Fundus photo — 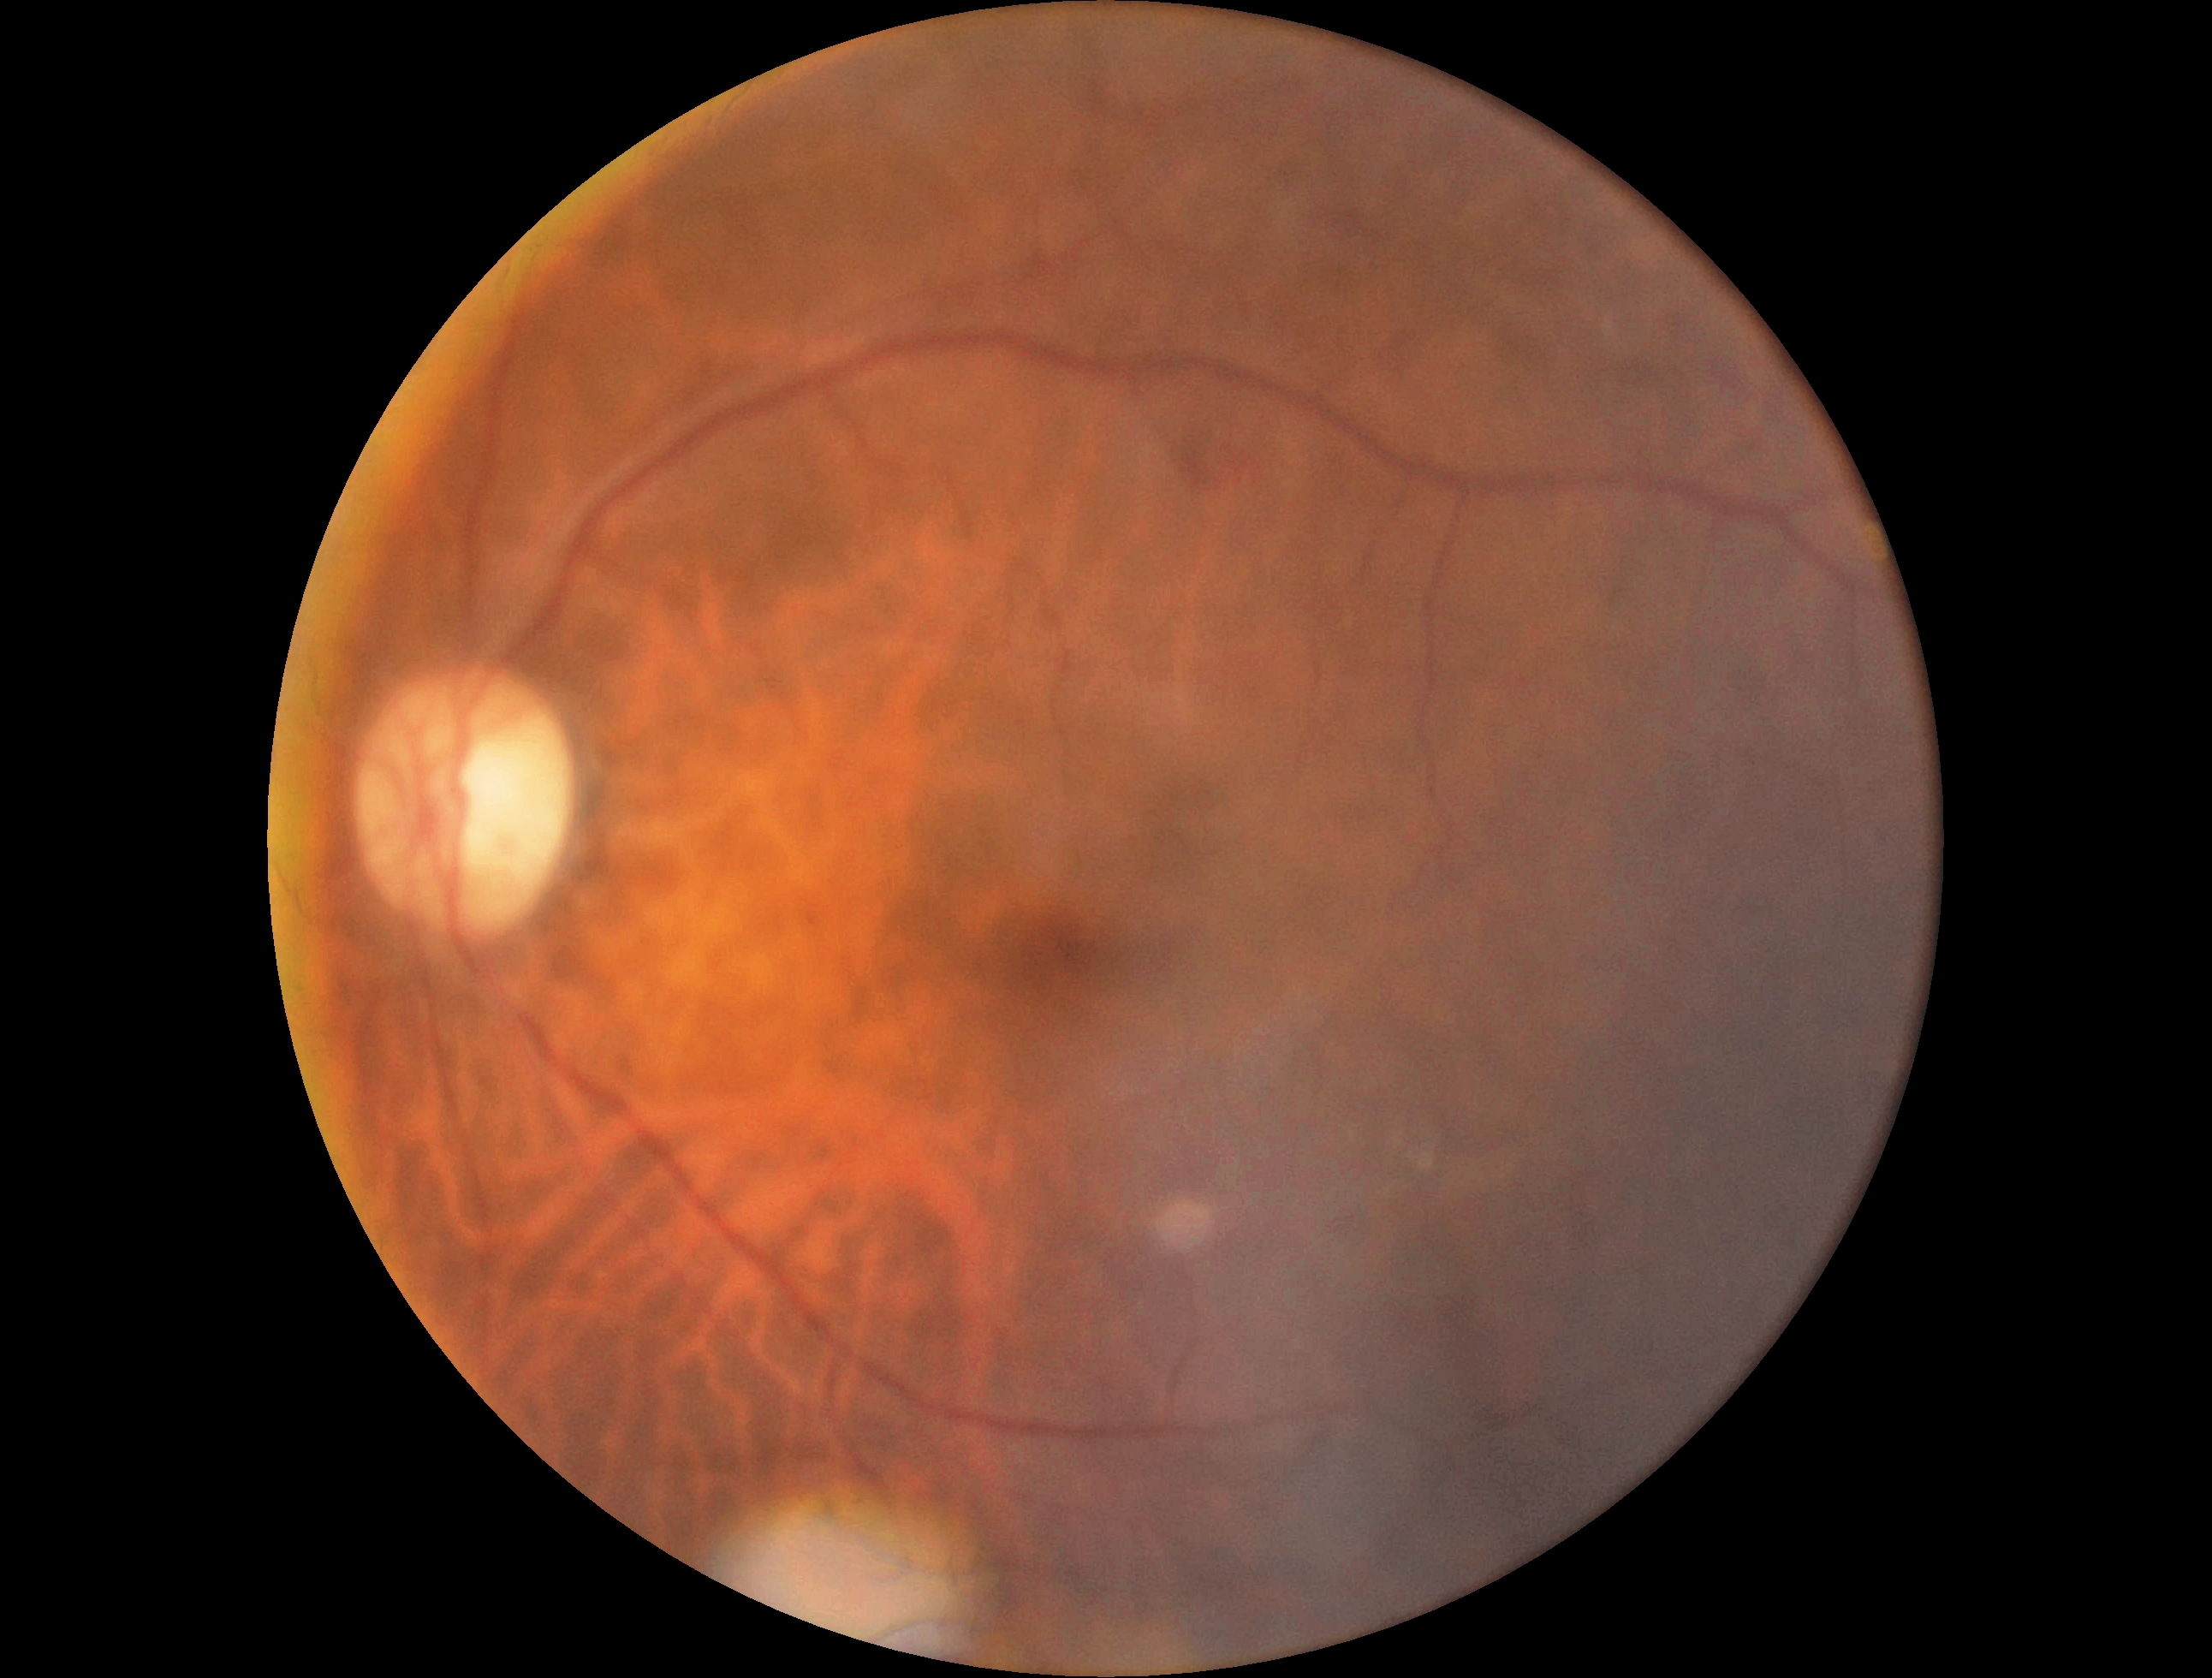
{
  "dr_grade": "grade 2 (moderate NPDR)"
}